Nonmydriatic:
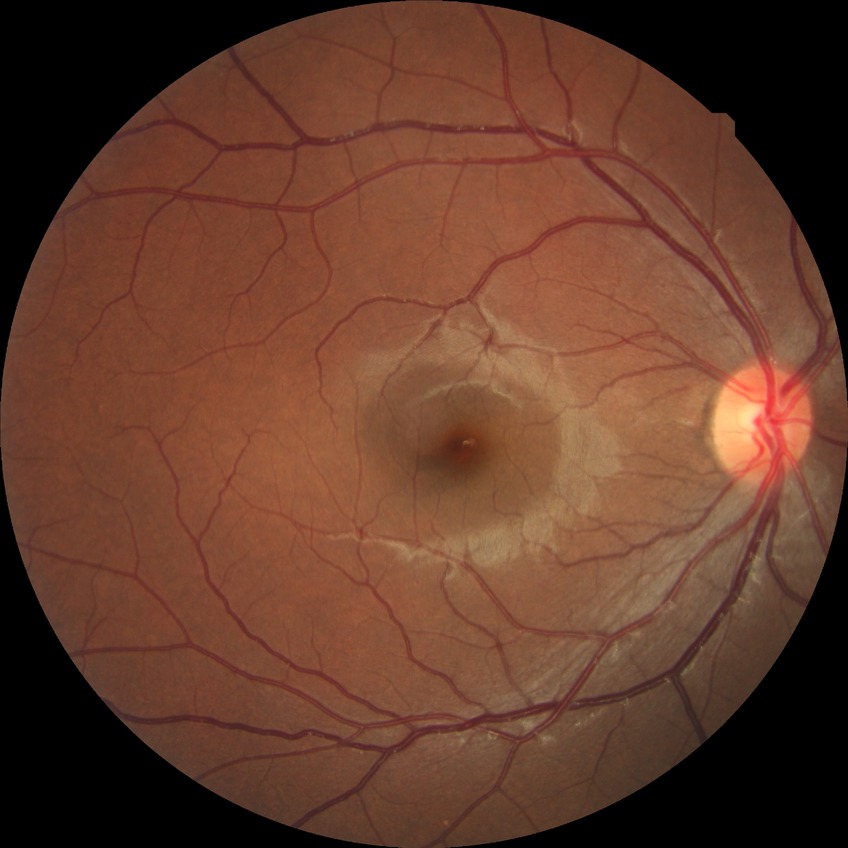
Modified Davis classification: no diabetic retinopathy.